CFP
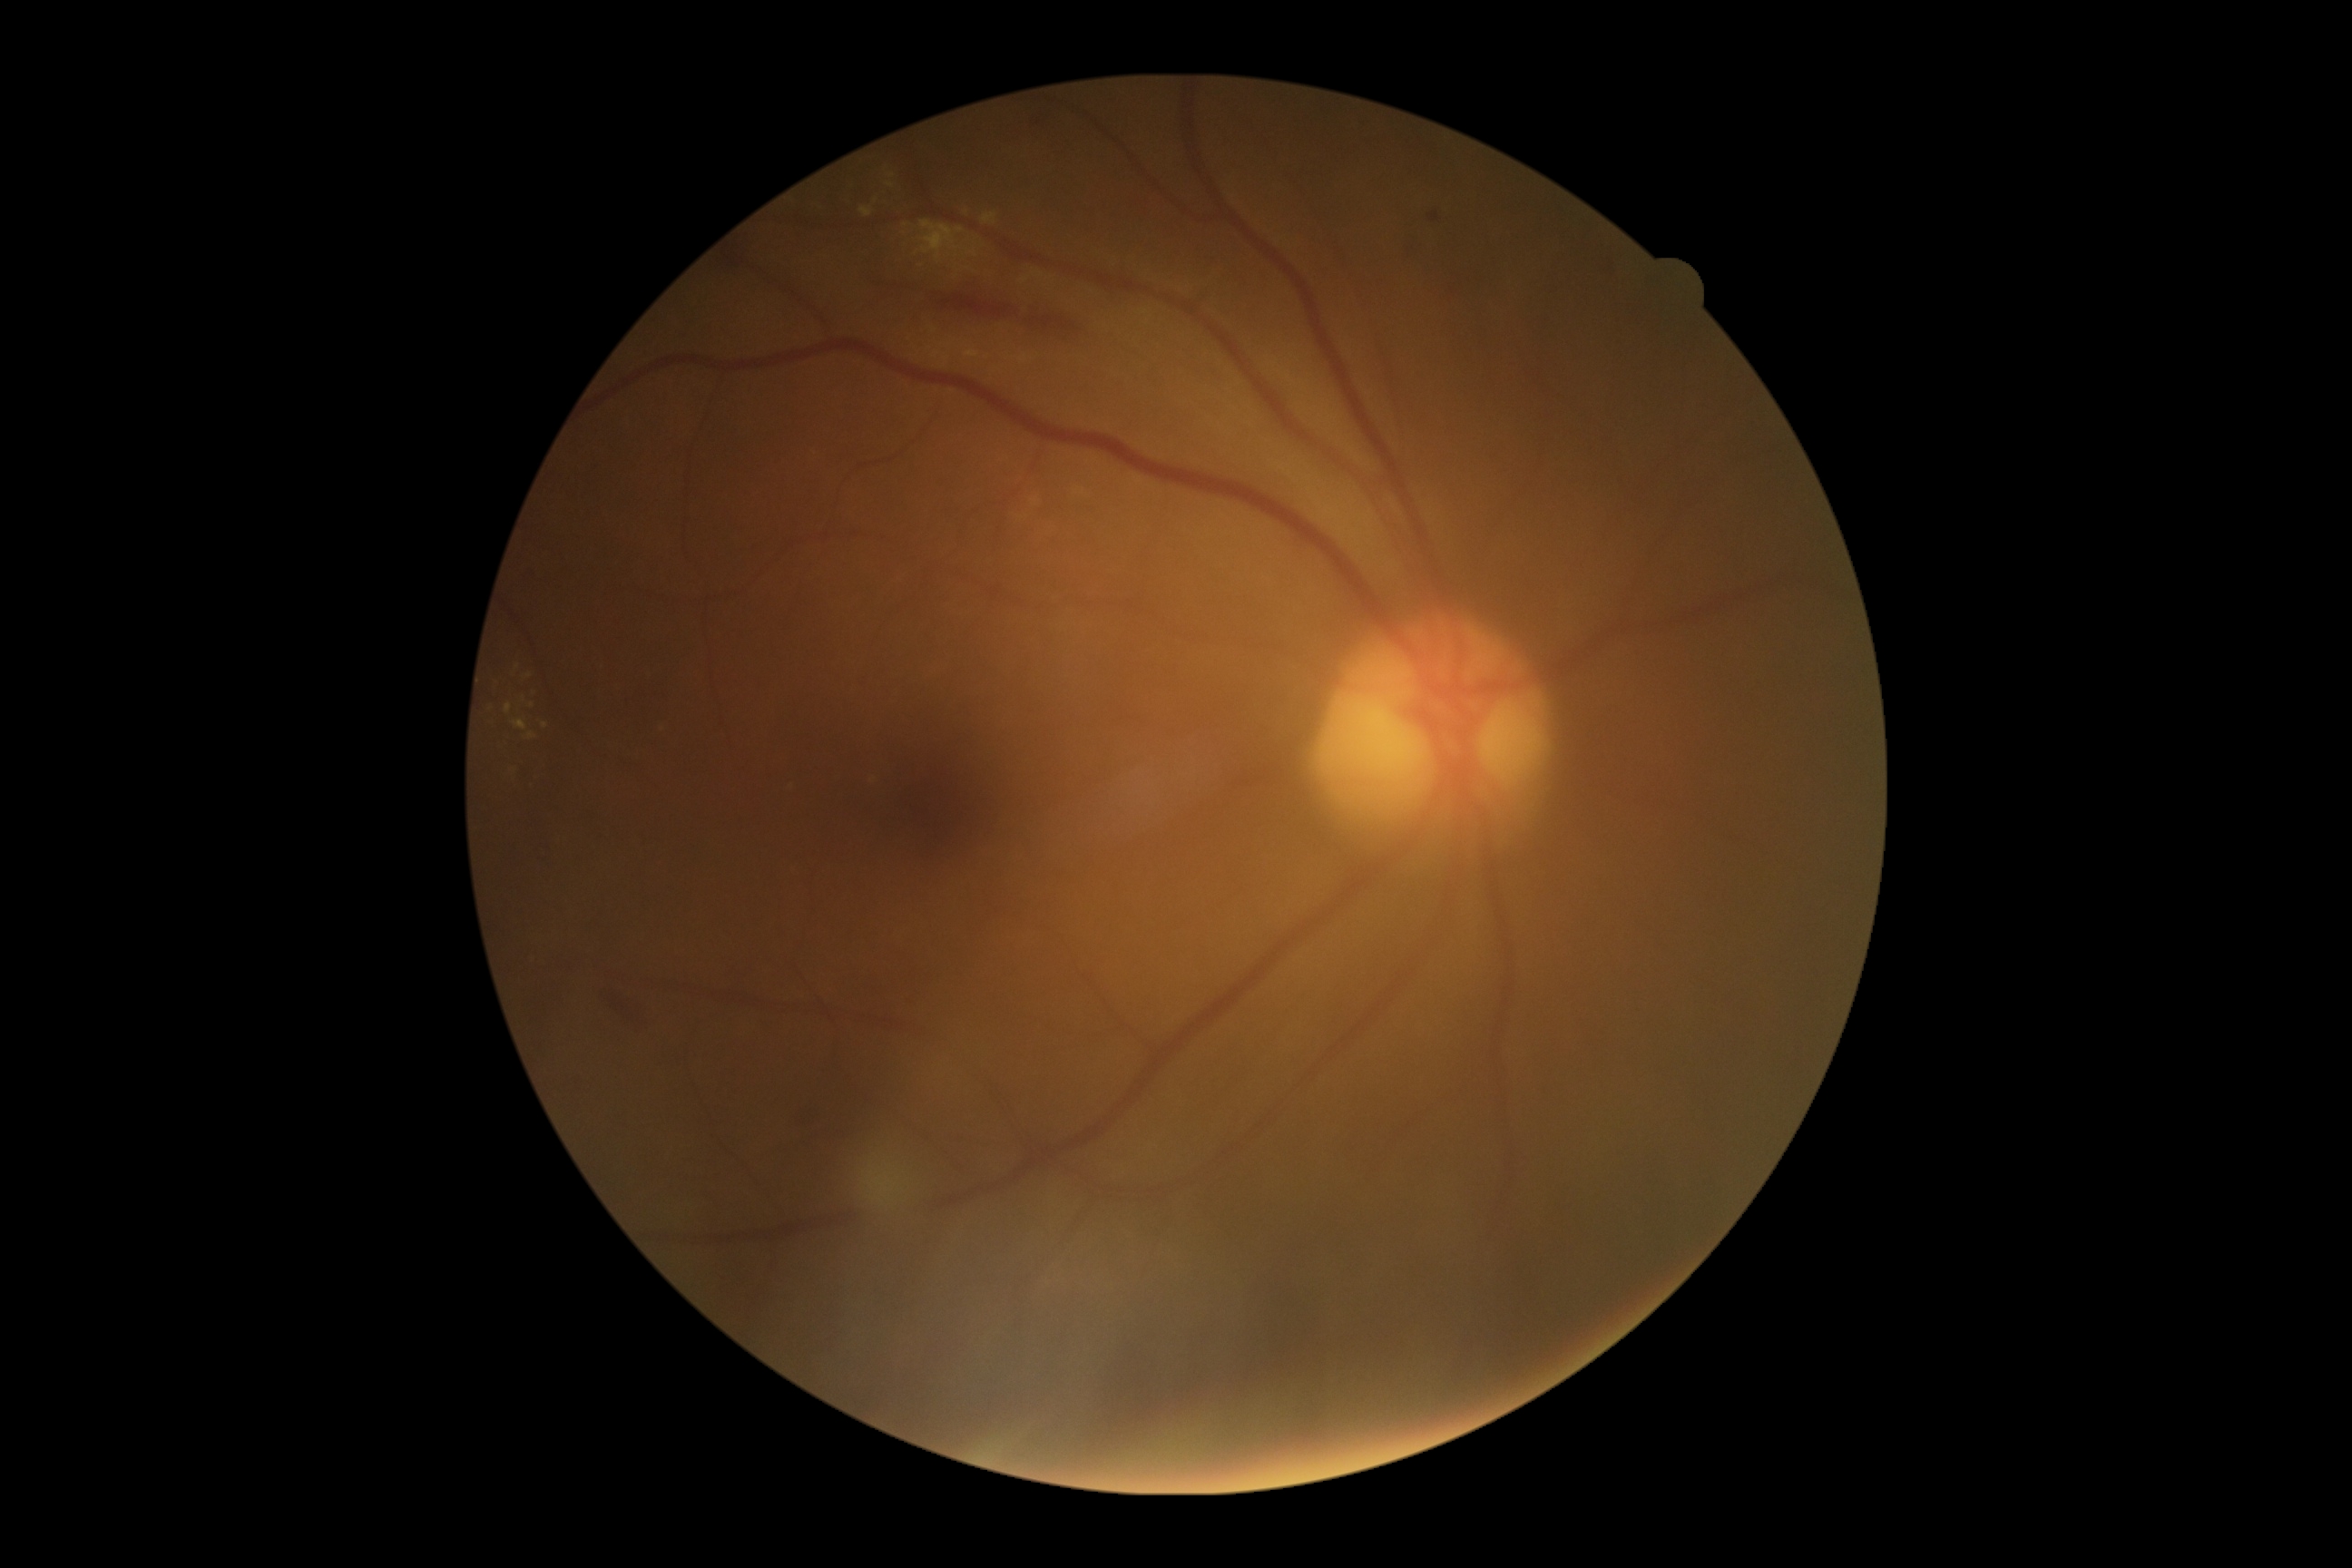 DR class: non-proliferative diabetic retinopathy. DR stage is grade 2 (moderate NPDR).